Fundus image cropped to the optic disc · 35° FOV before cropping.
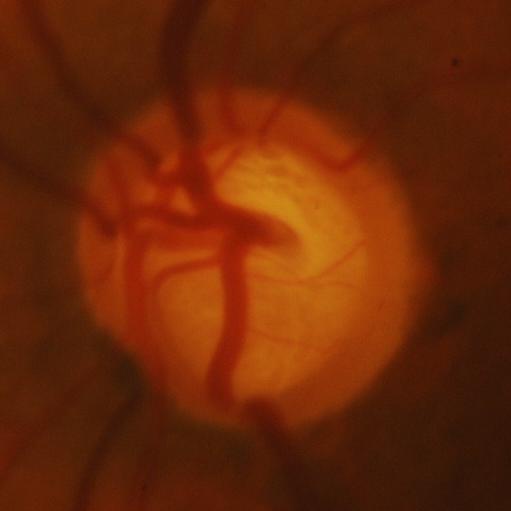

Glaucoma status = evidence of glaucoma.